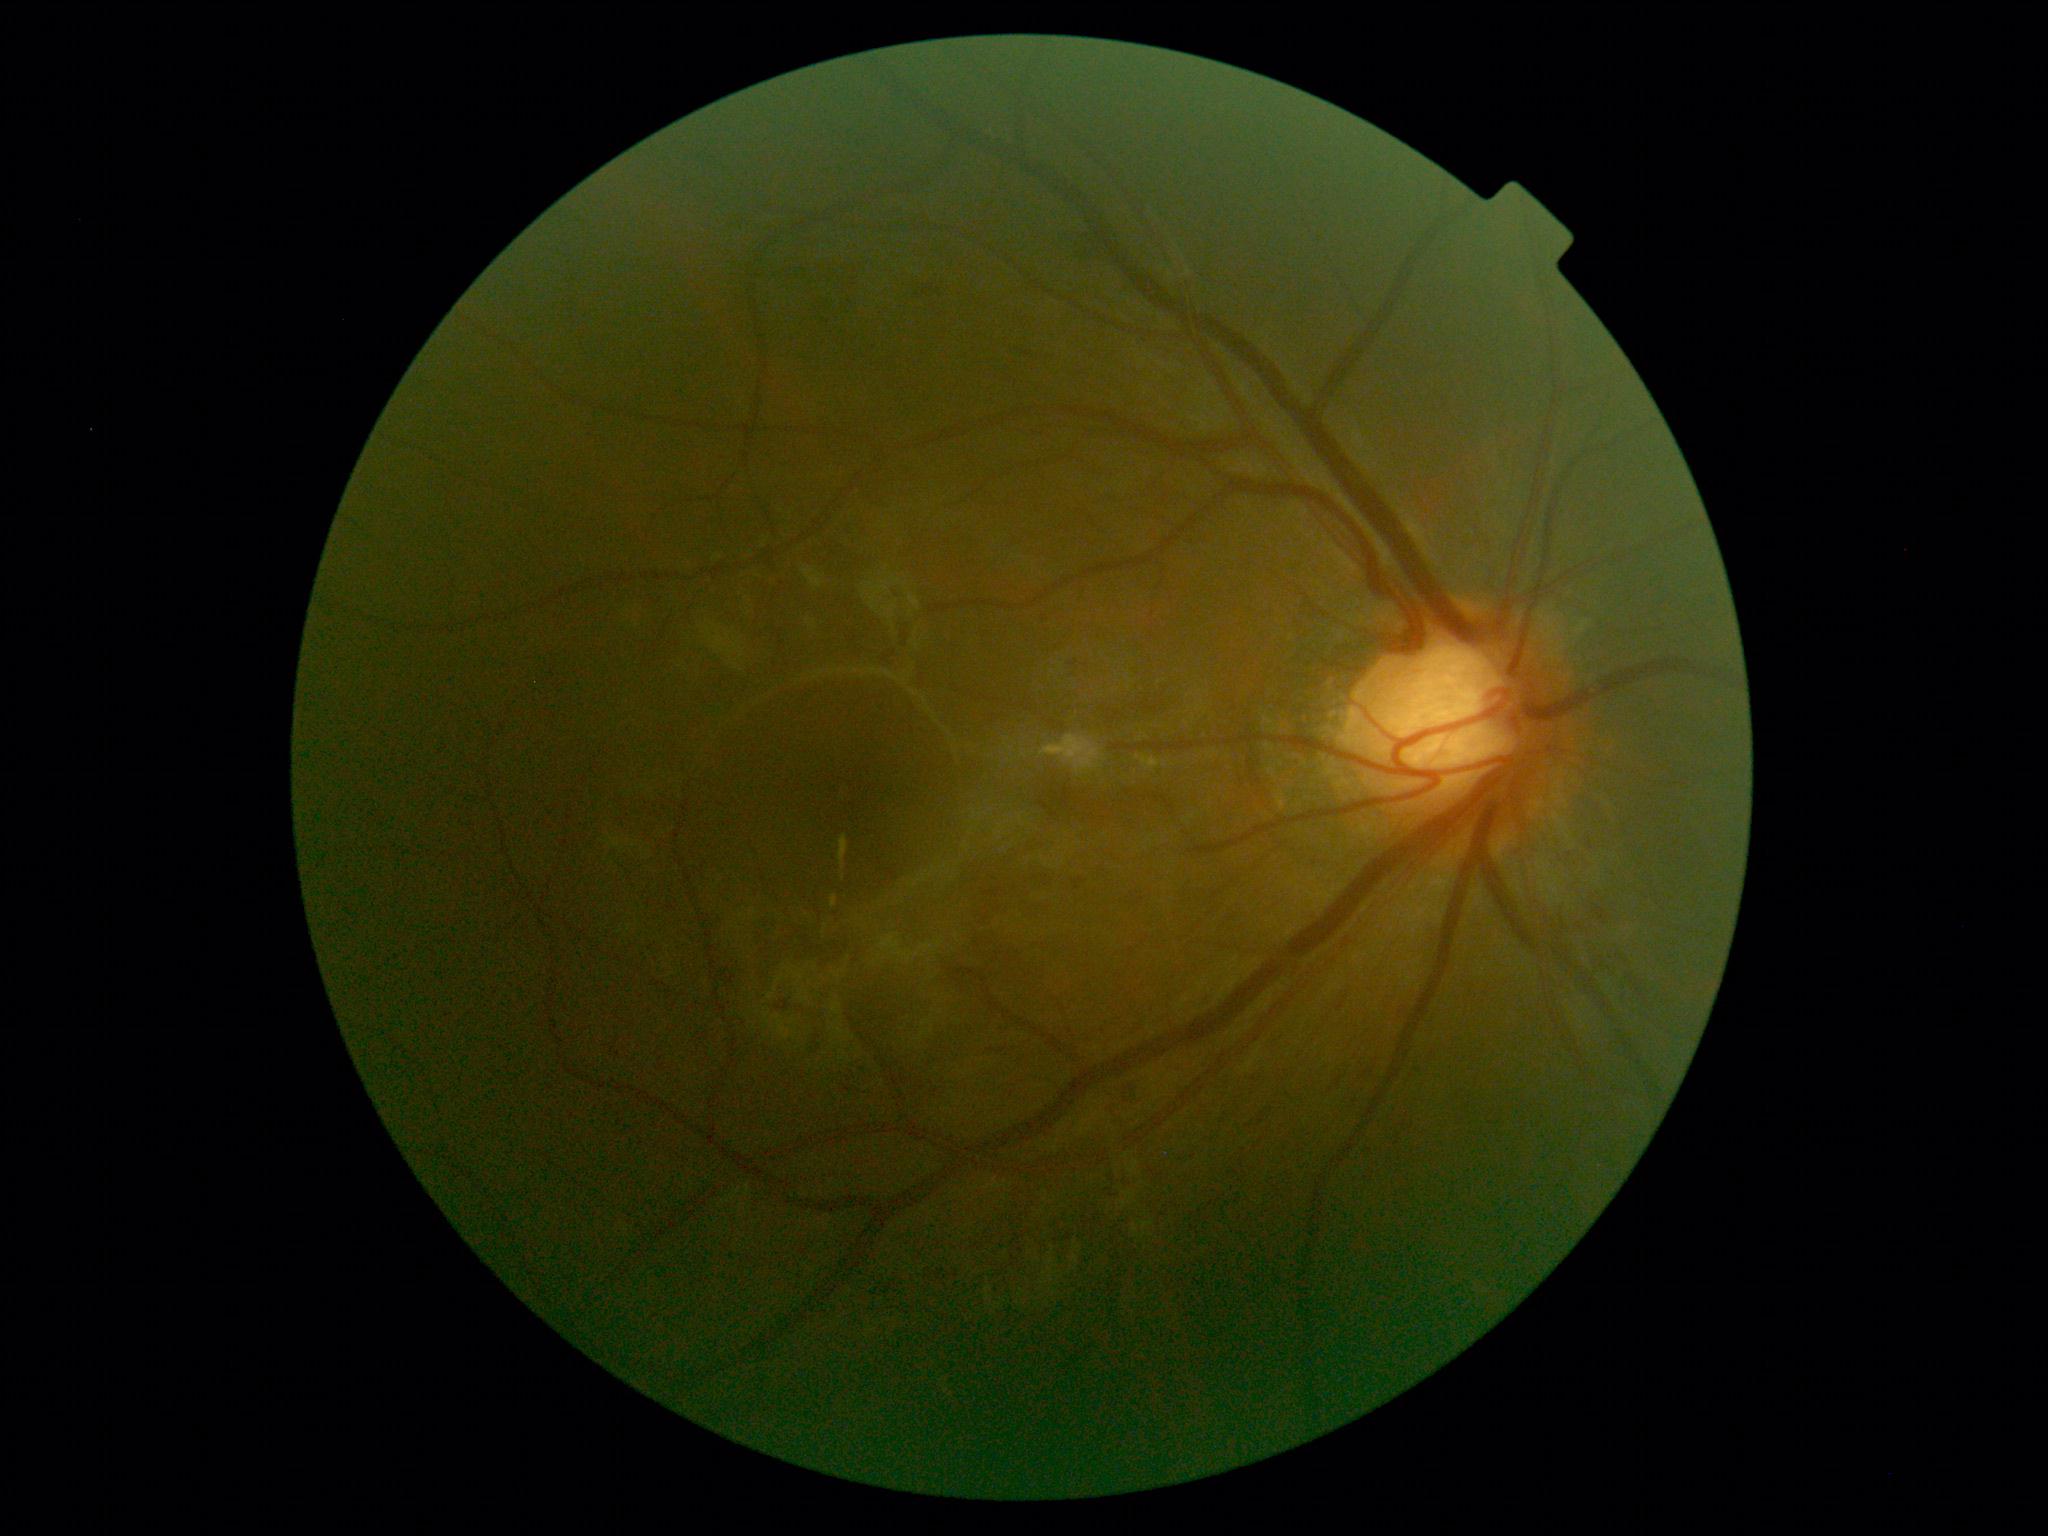

DR = 2.